CFP:
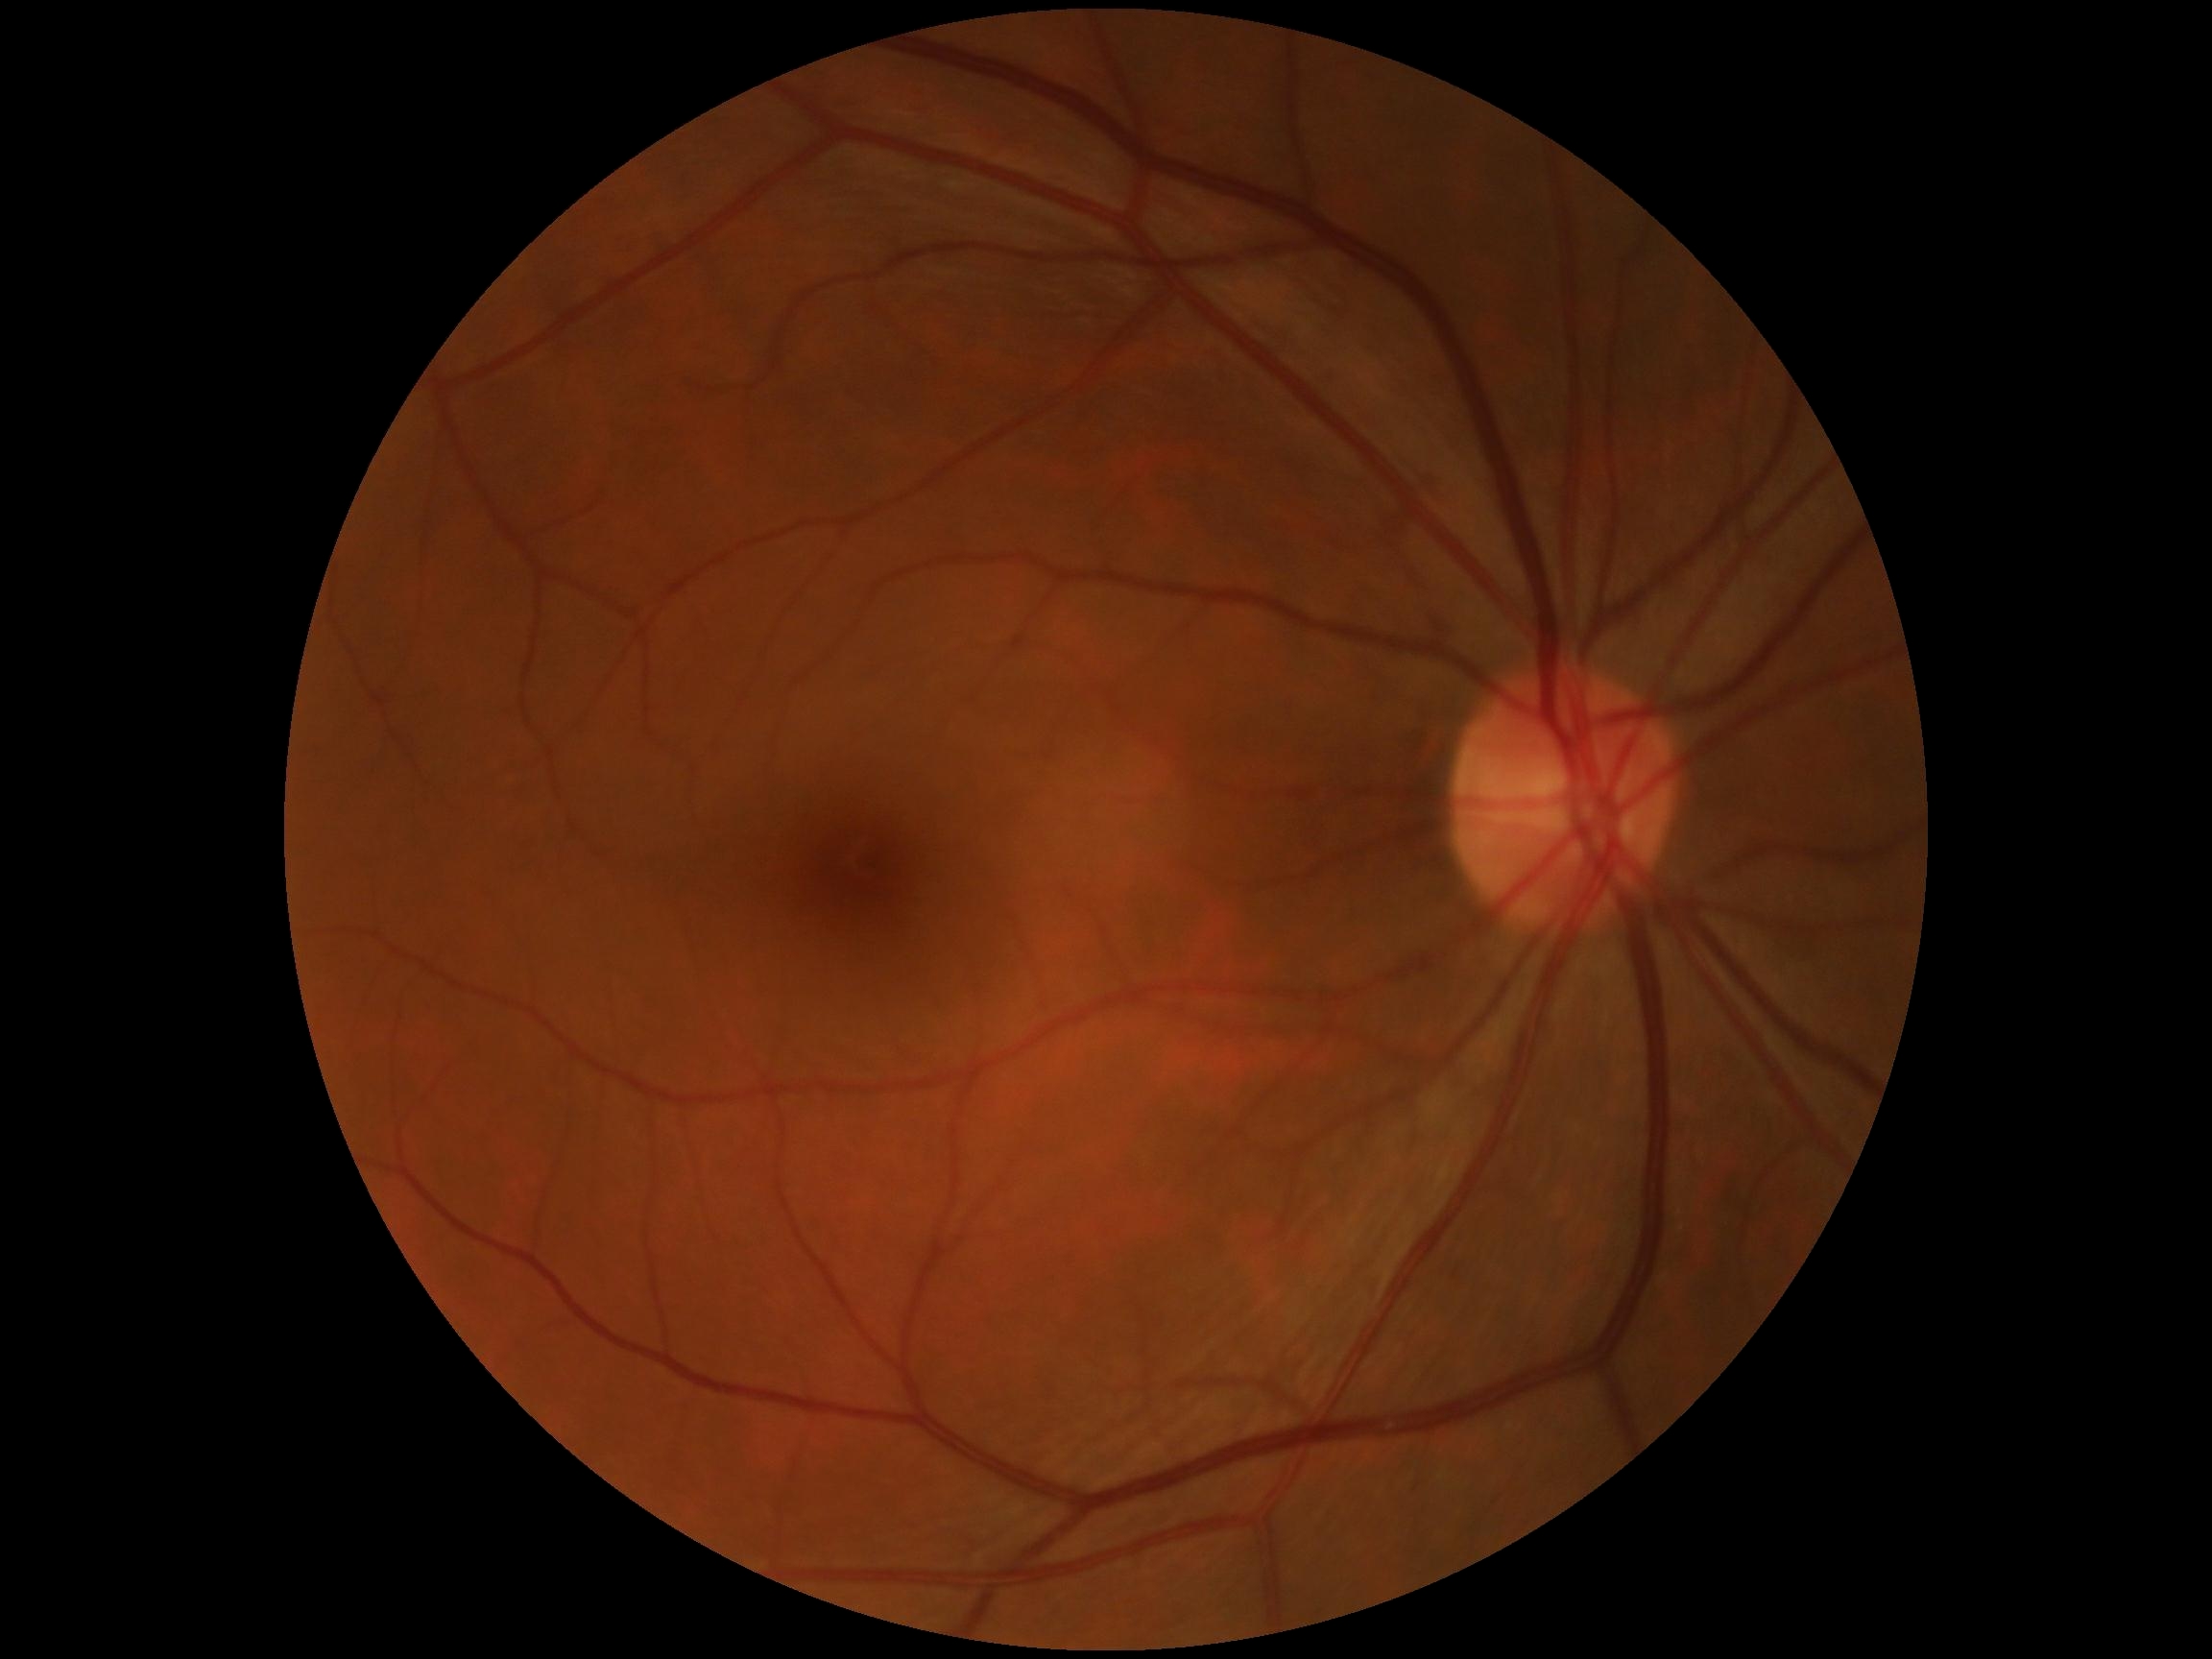 {
  "dr_grade": "no apparent diabetic retinopathy (0)",
  "dr_impression": "negative for DR"
}